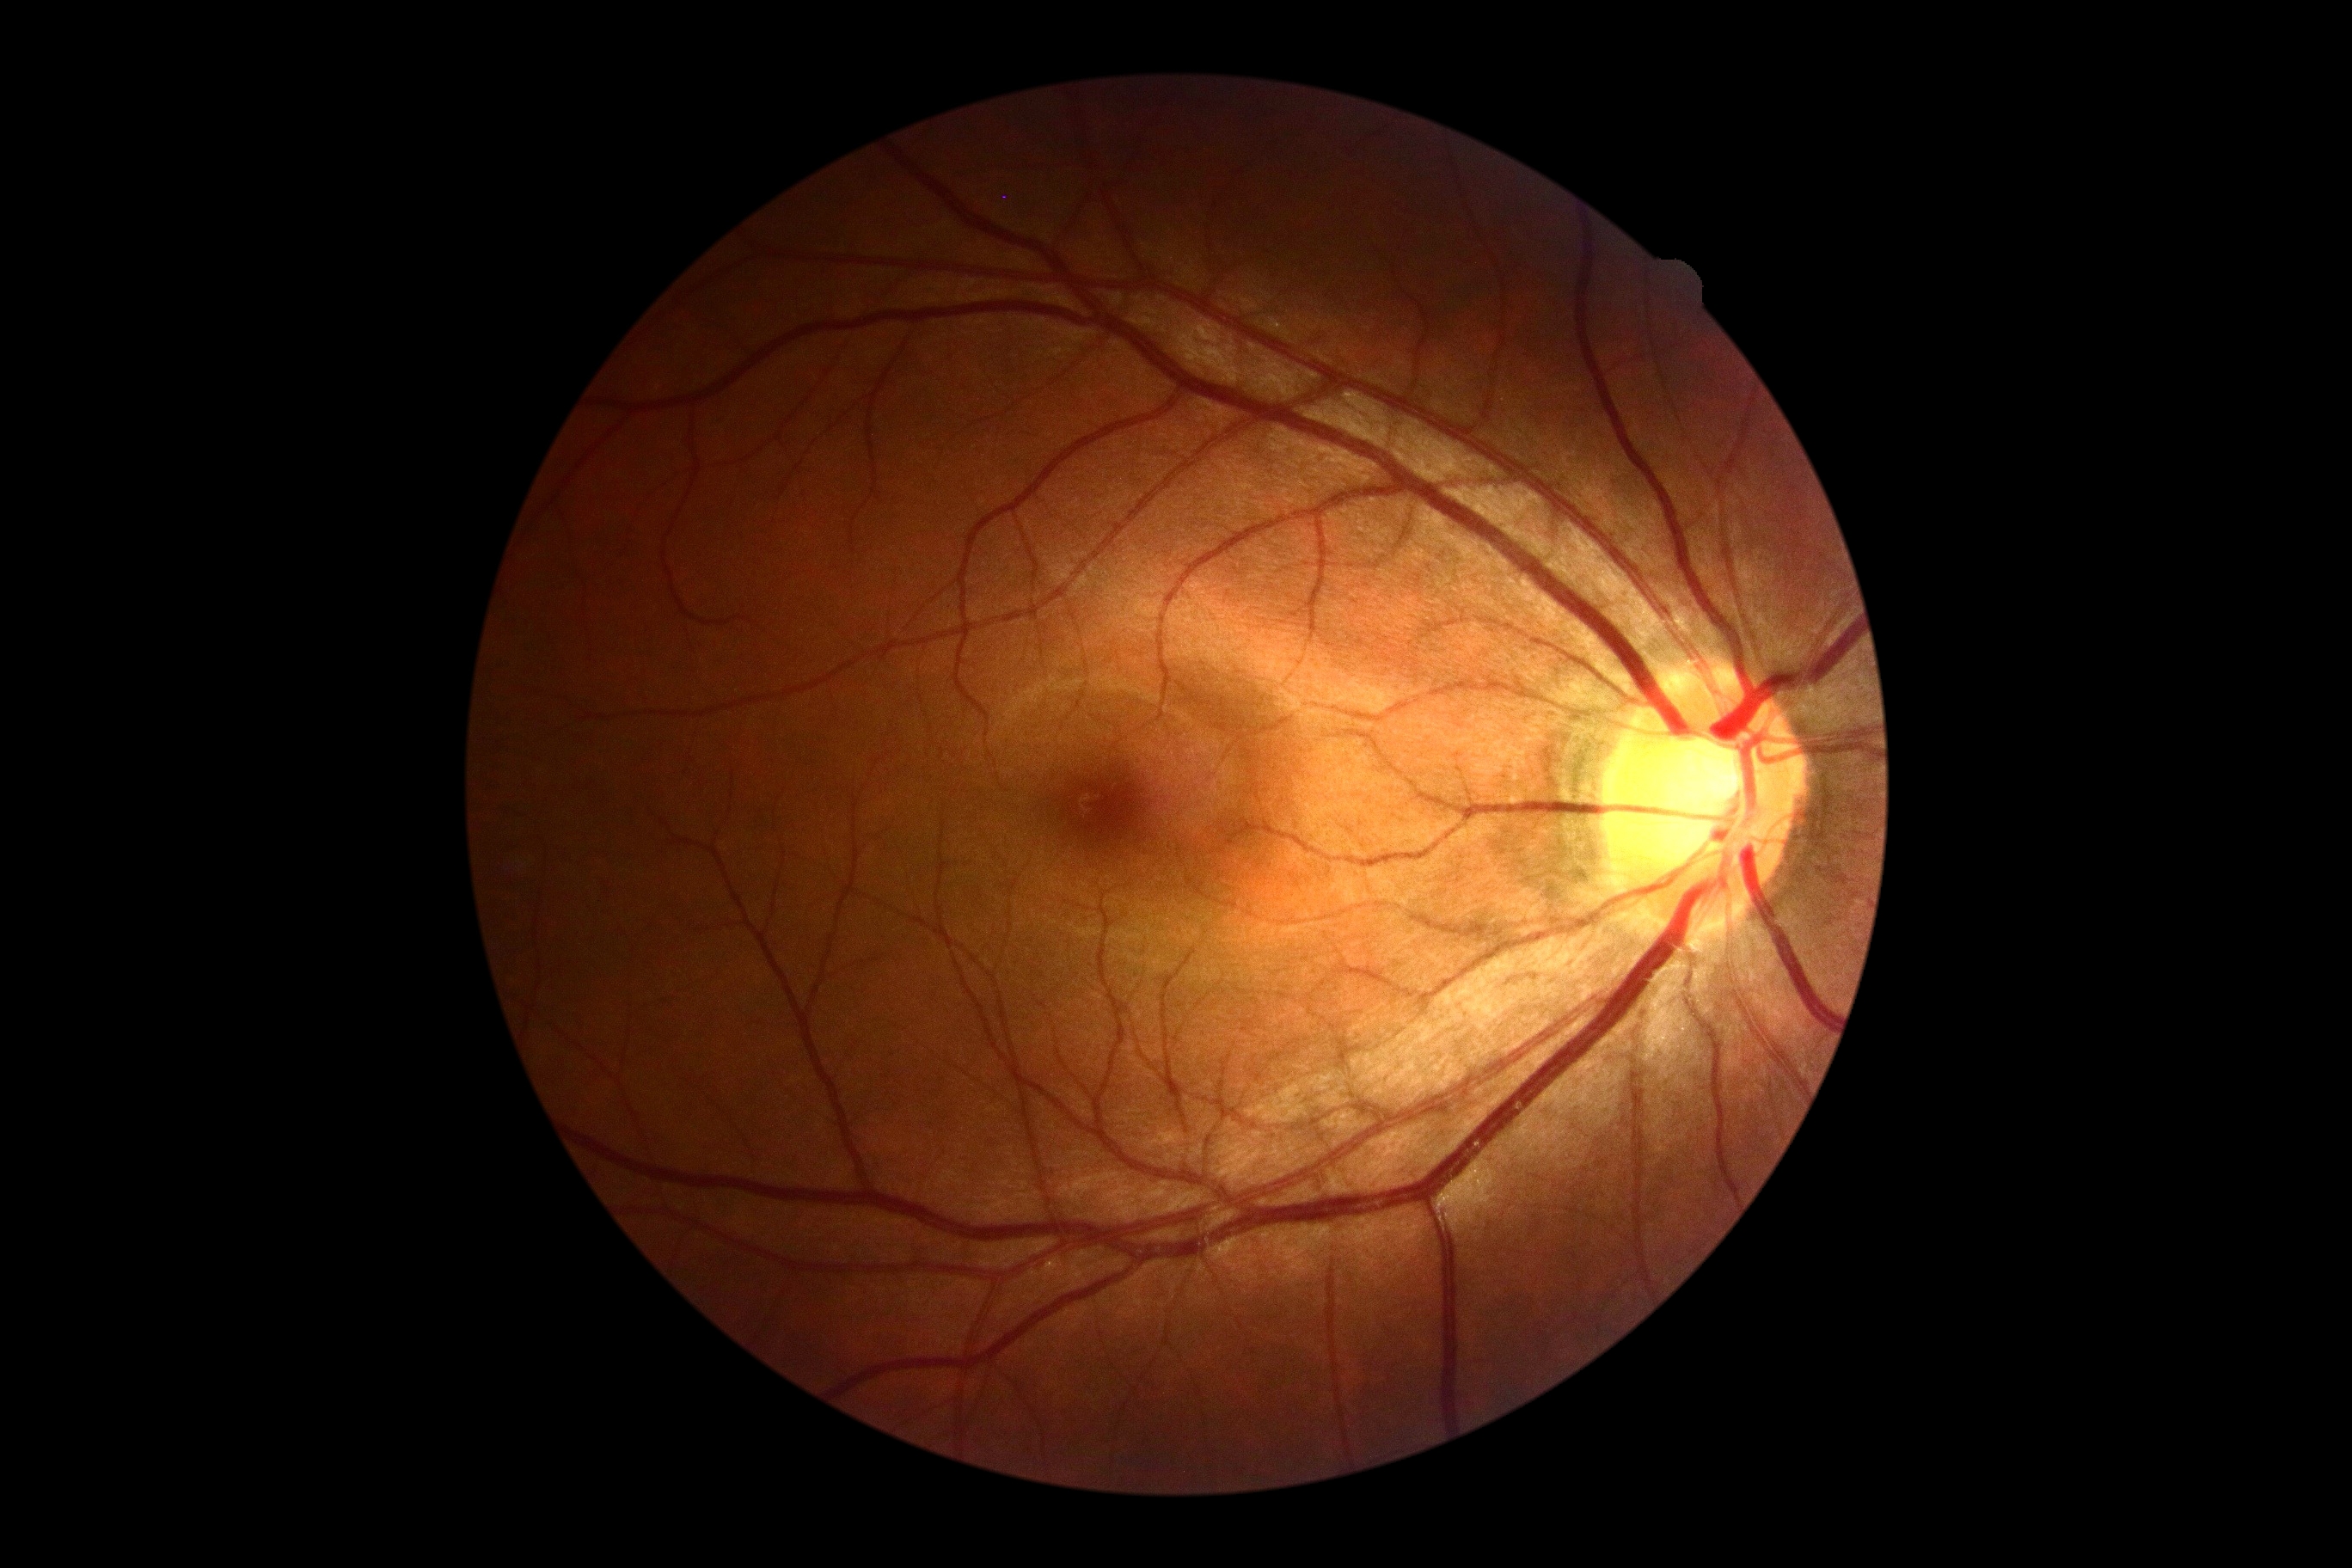 retinopathy grade: 0; DR impression: no signs of DR.